Fundus photo · 45° FOV.
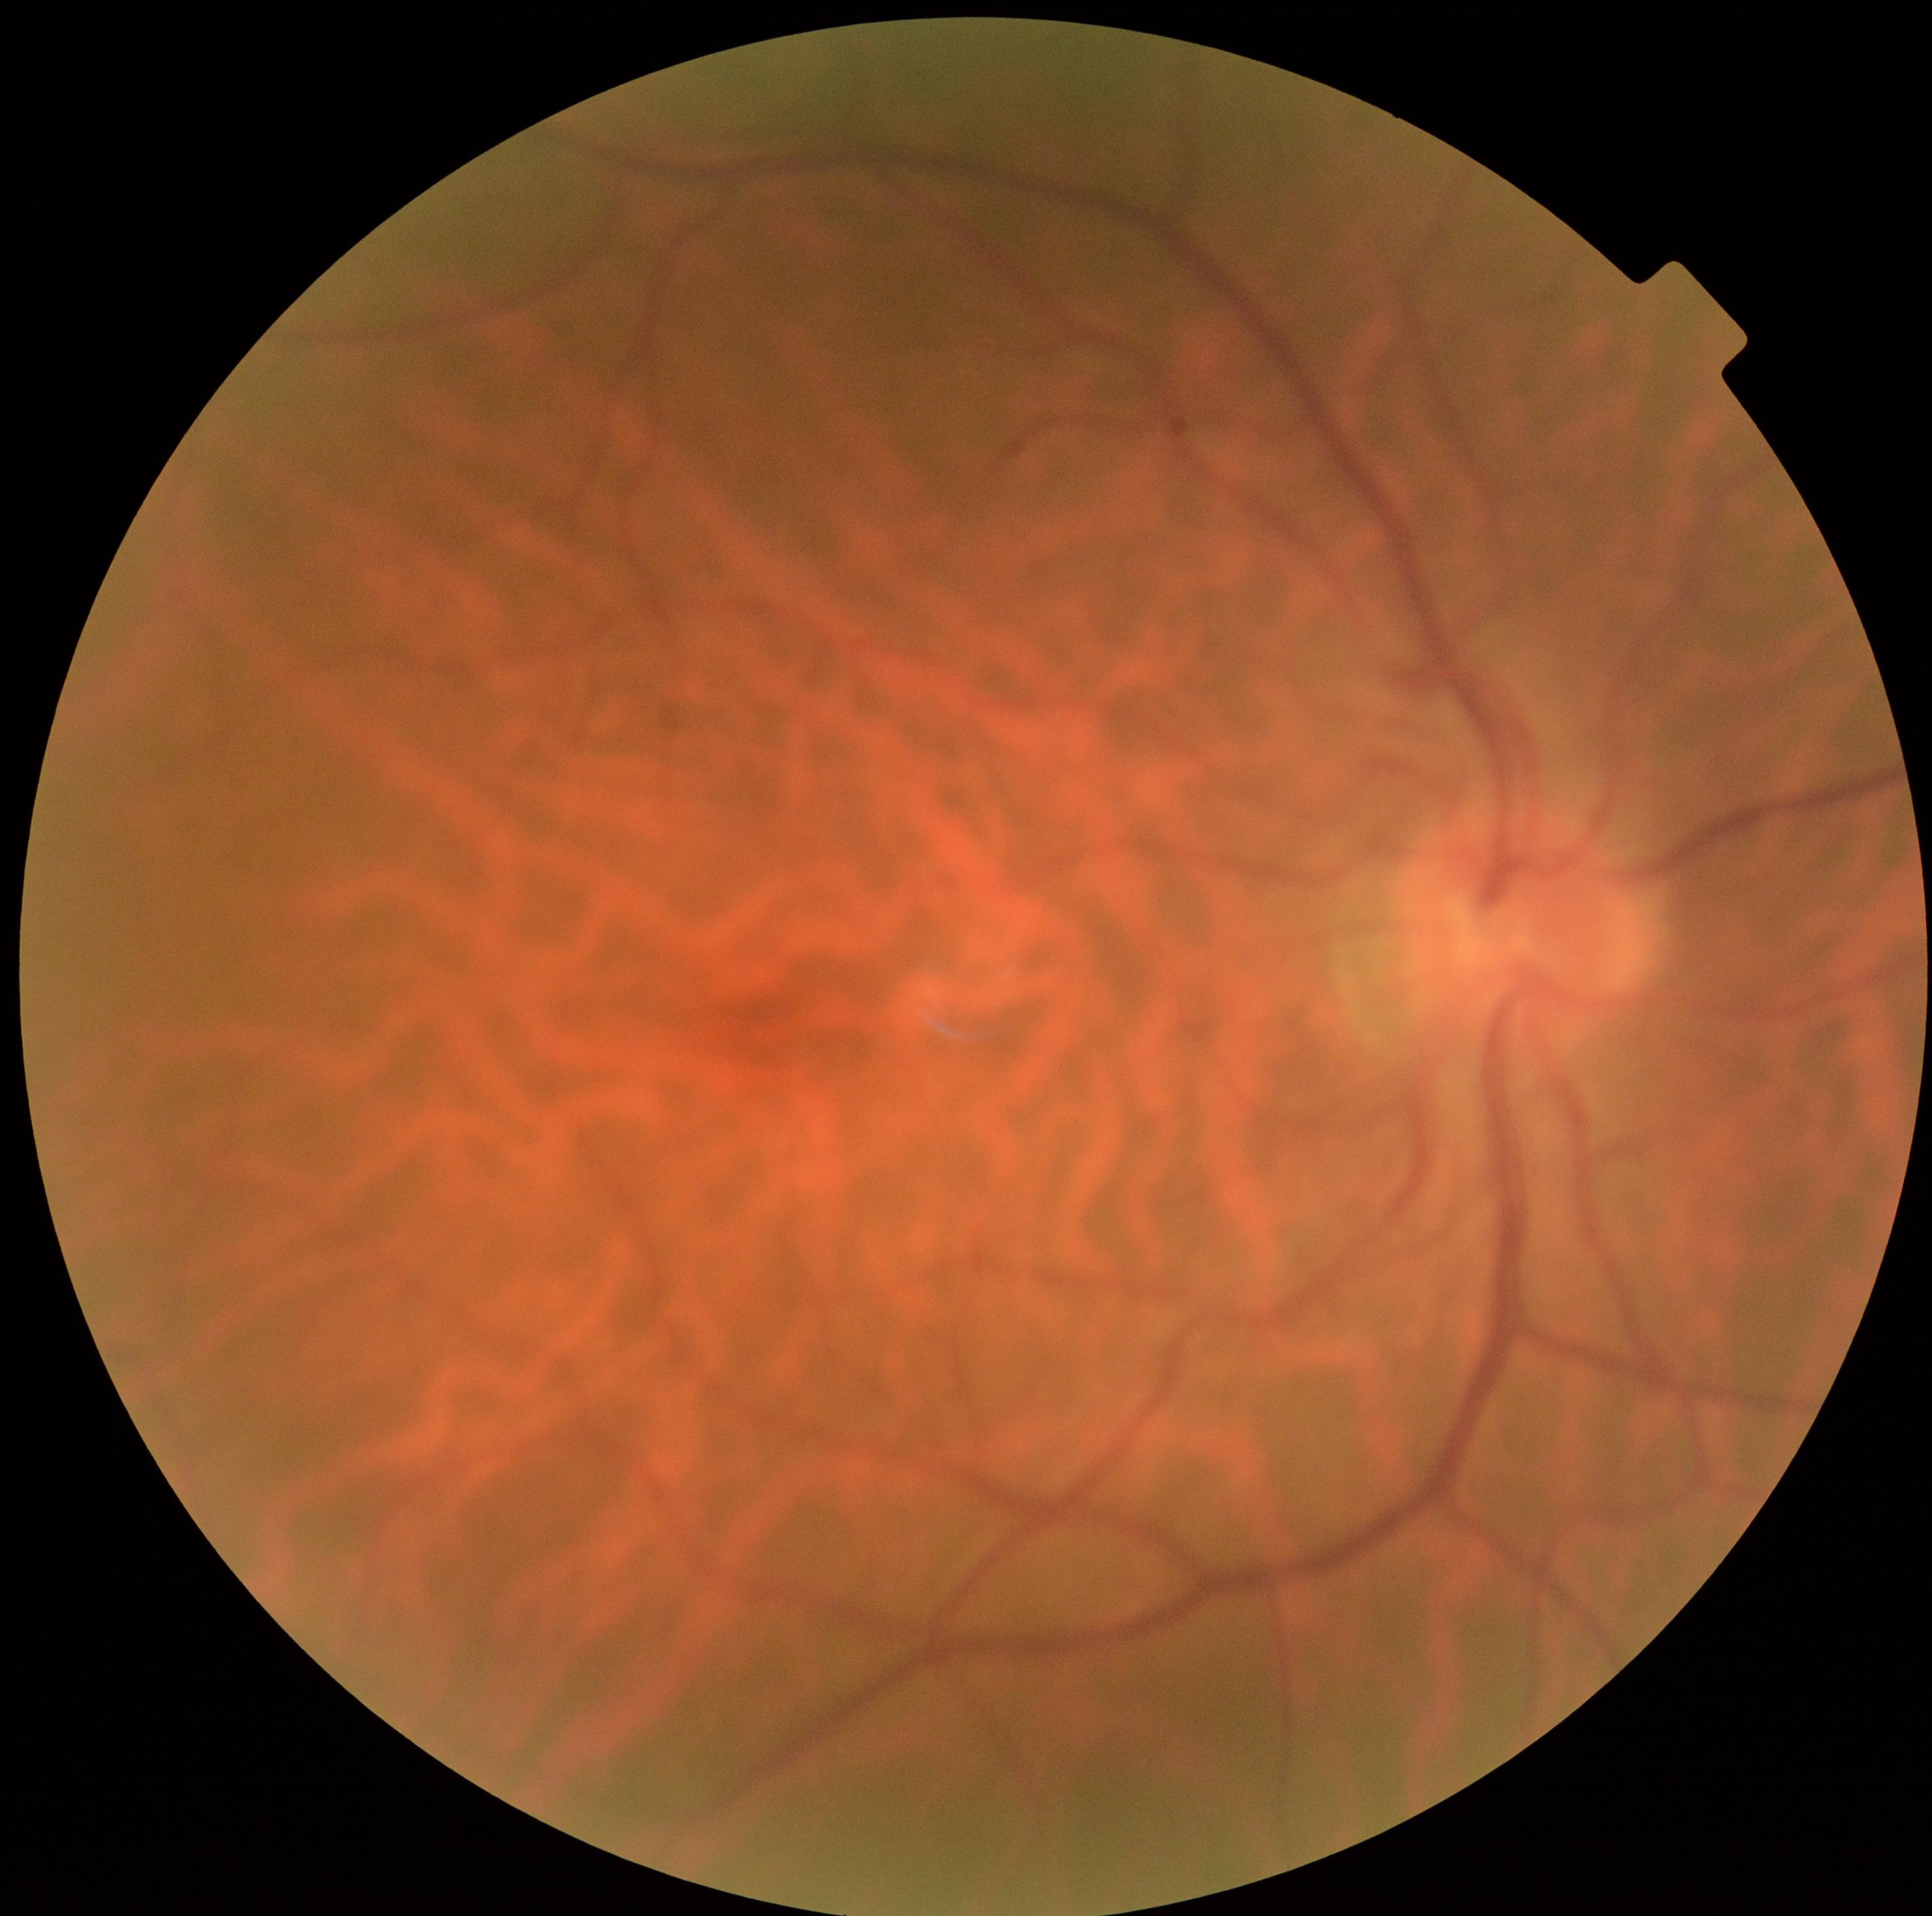

Diabetic retinopathy is 0/4.
No signs of diabetic retinopathy.